Image size 1240x1240 · camera: Phoenix ICON (100° FOV) · infant wide-field fundus photograph: 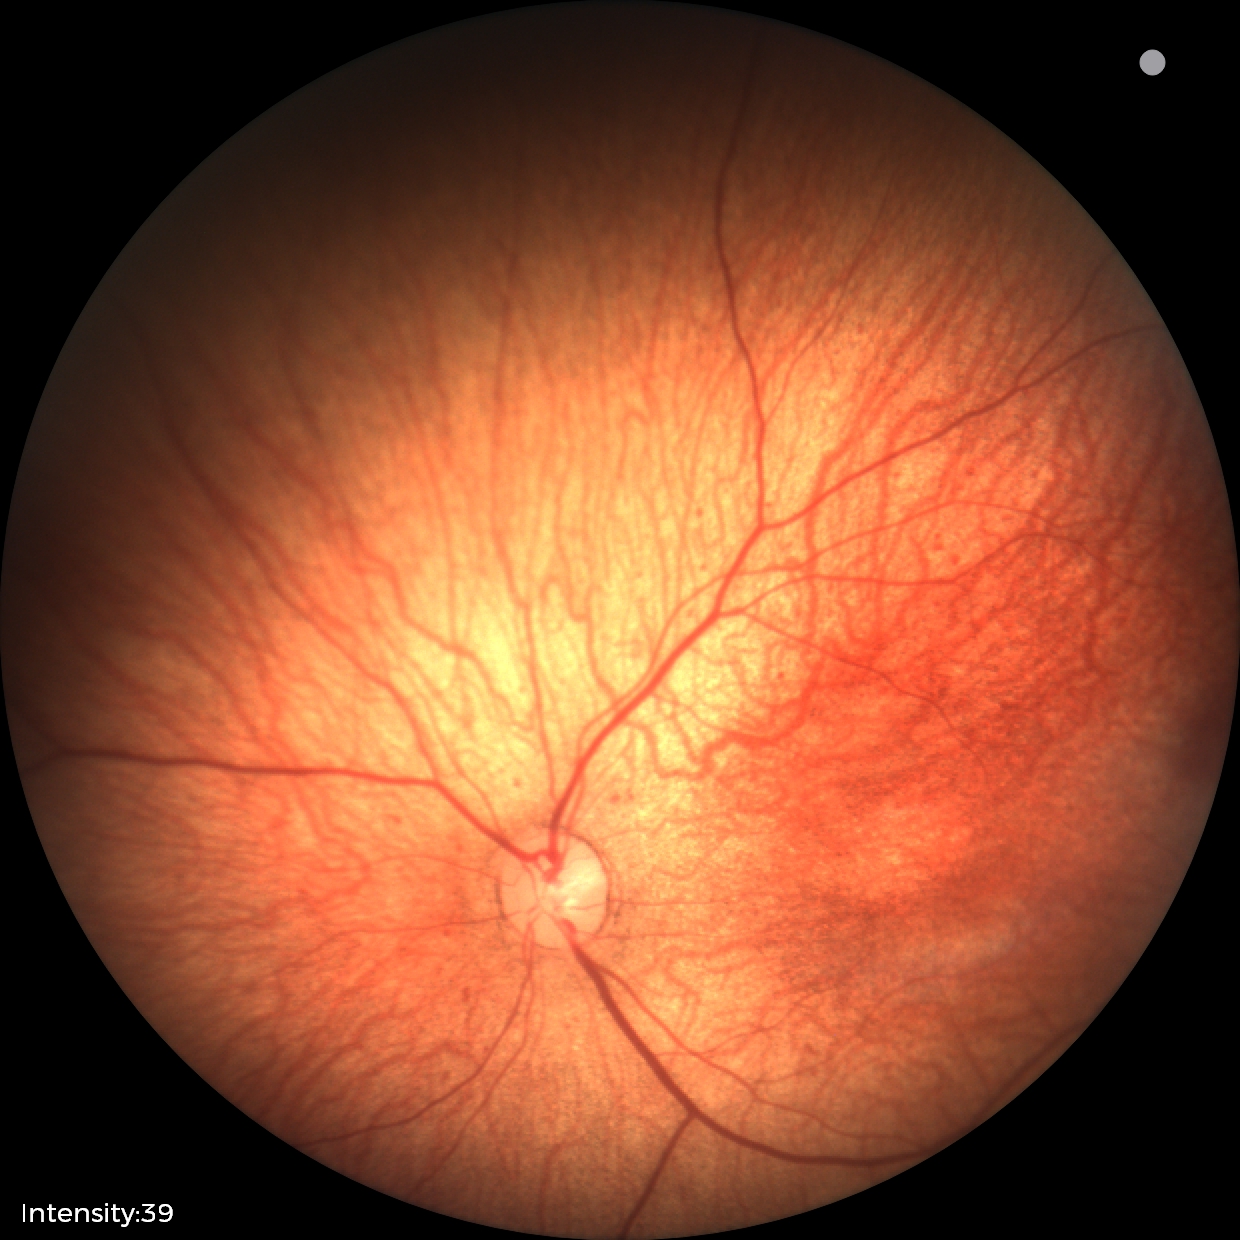

Physiological retinal appearance for postconceptual age.